Wide-field contact fundus photograph of an infant:
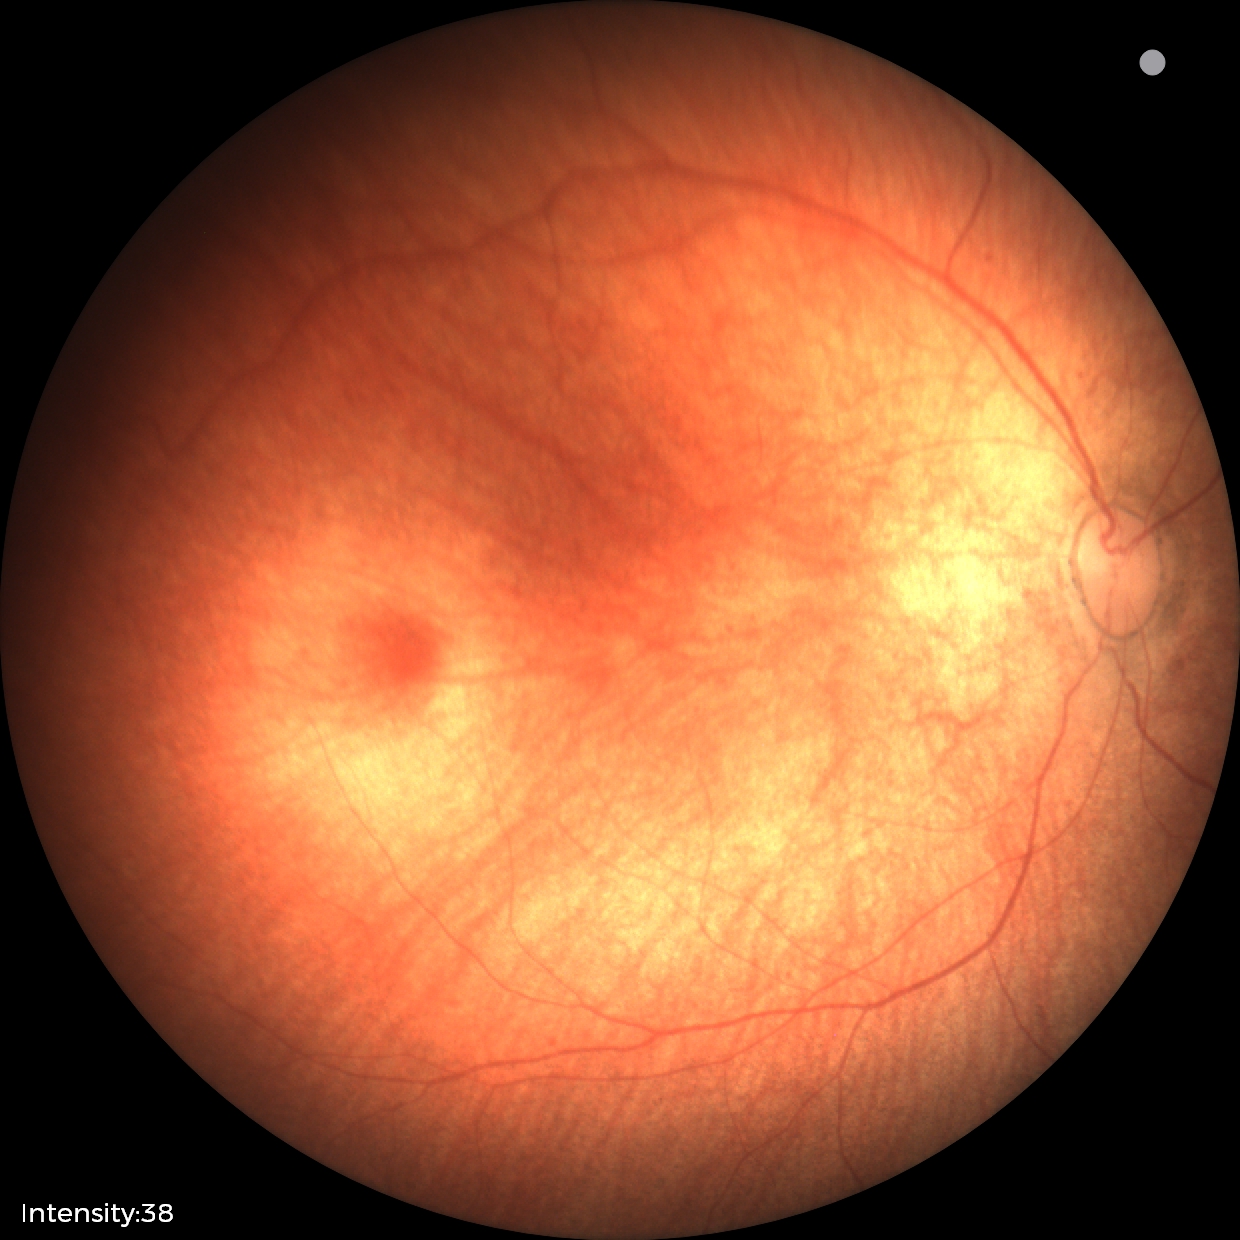

Screening diagnosis: no abnormal retinal findings.